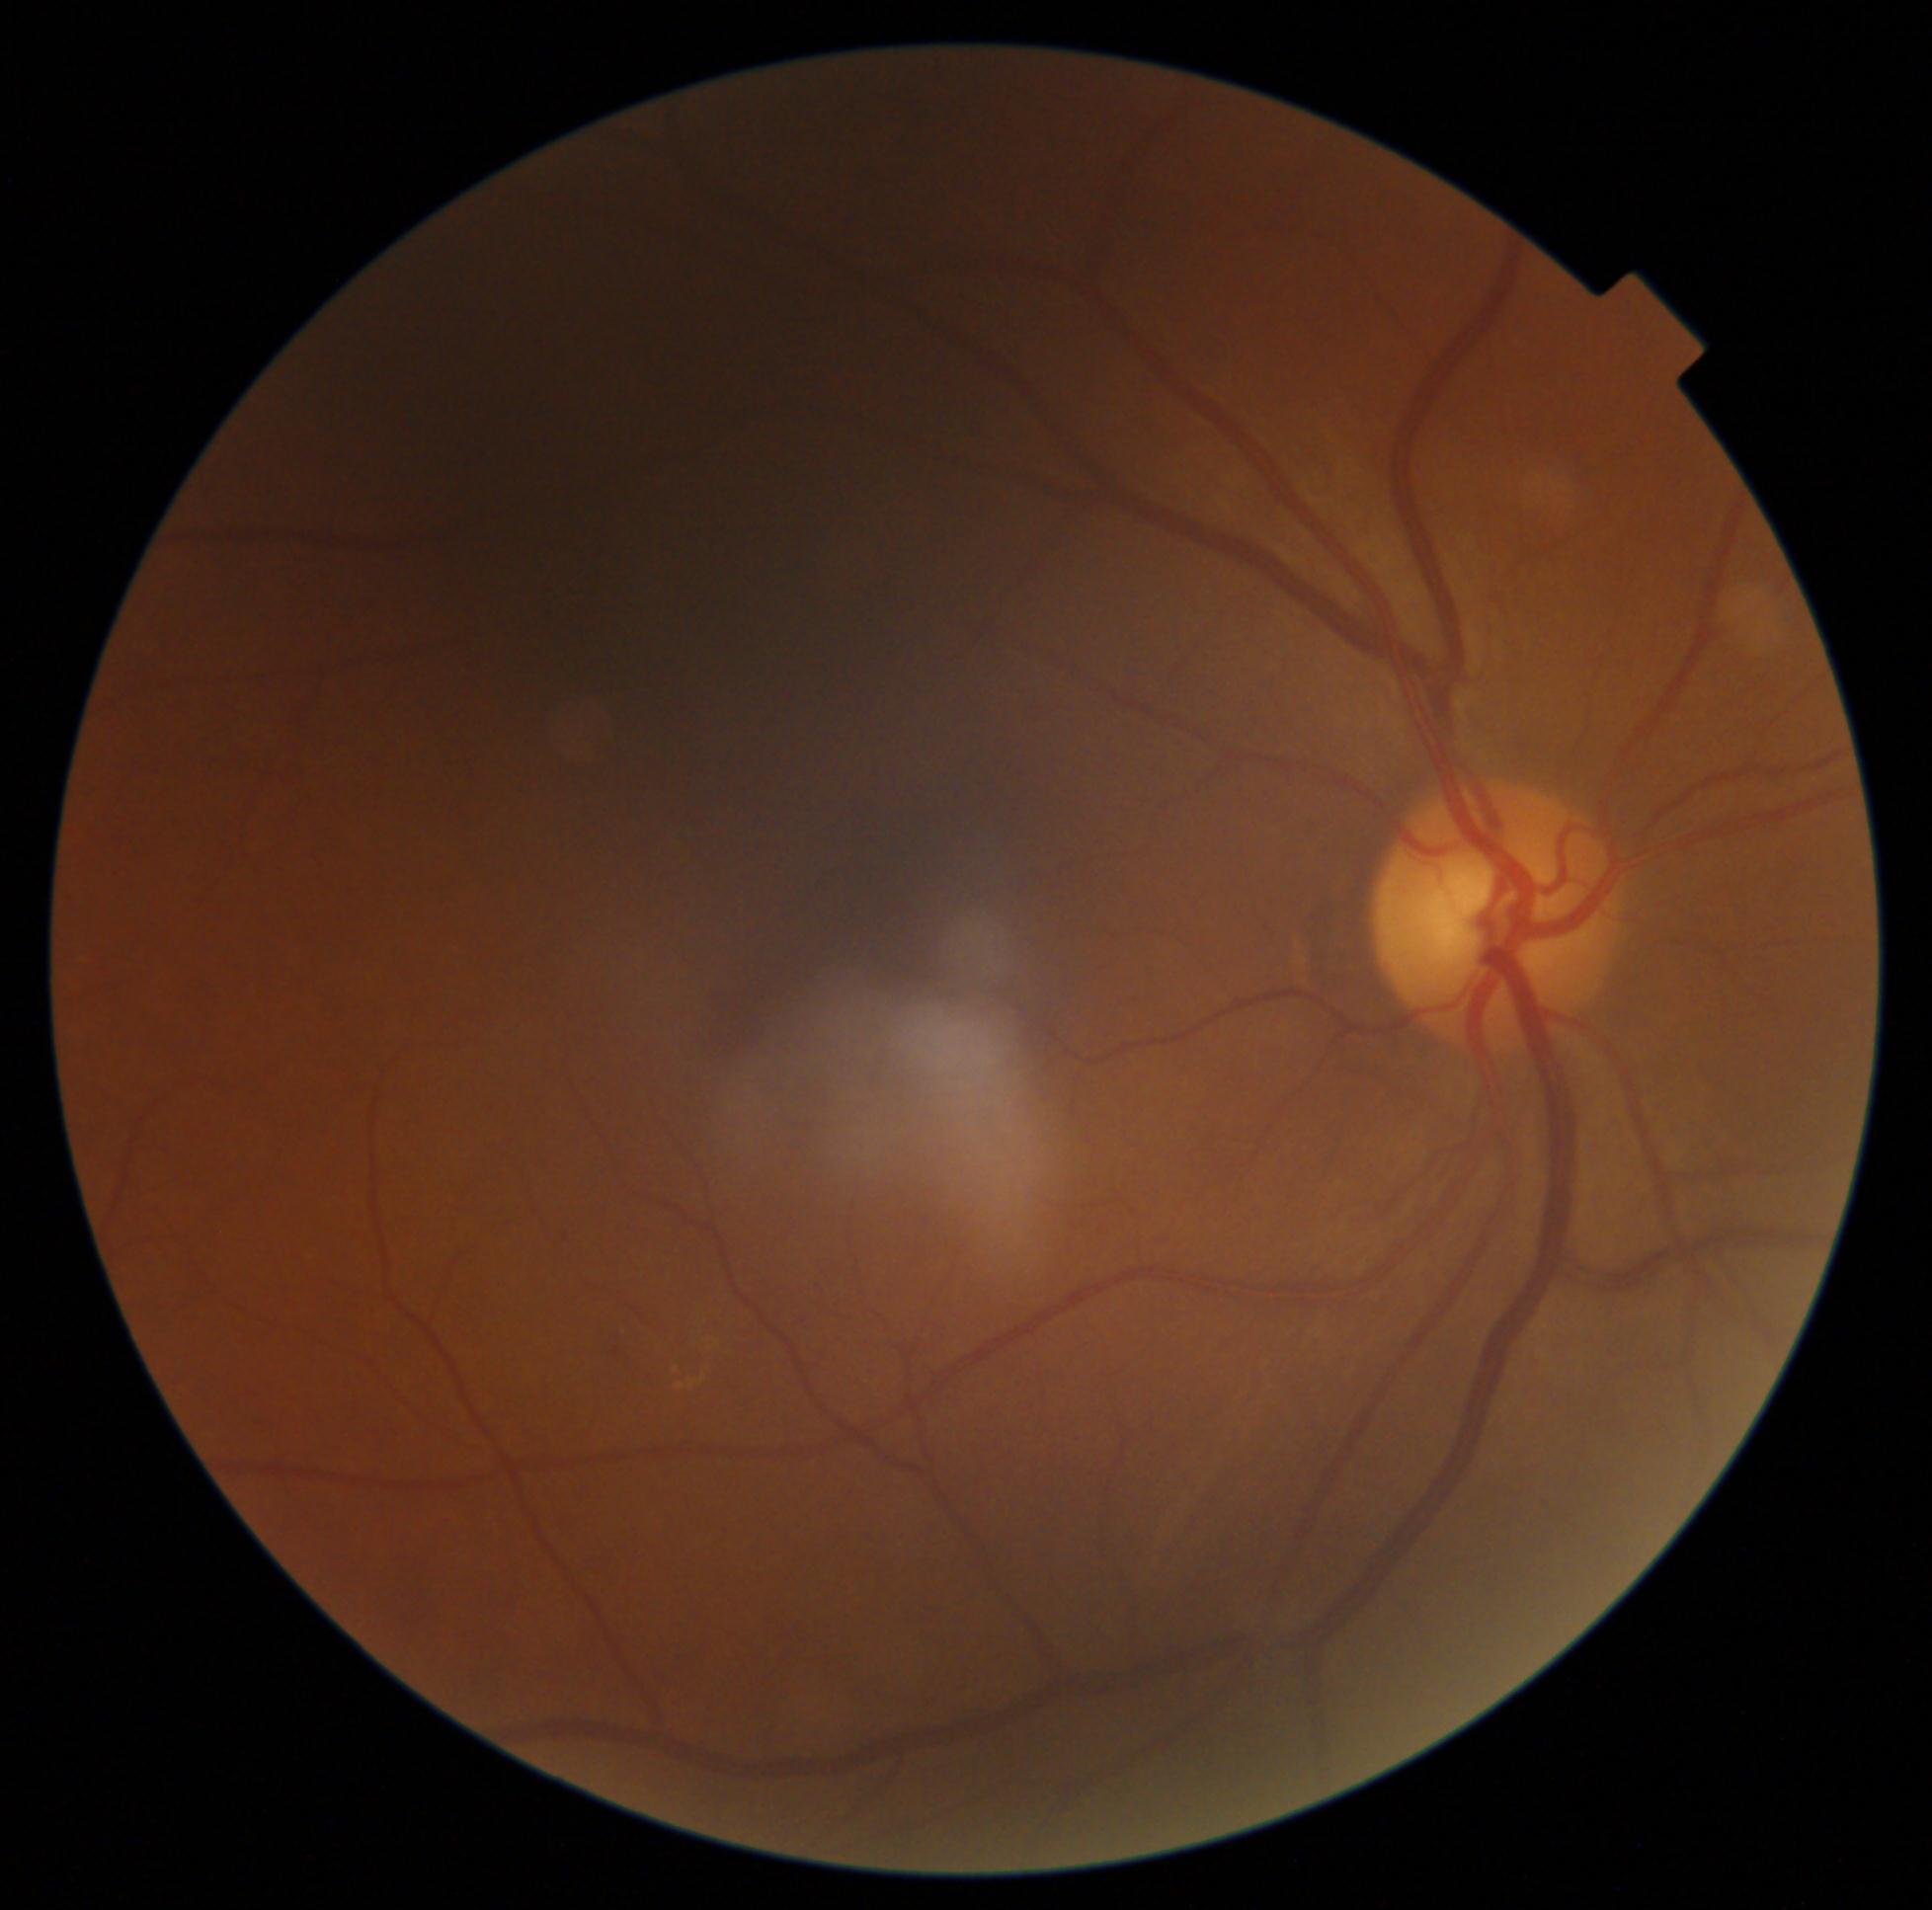
Diabetic retinopathy (DR): 2/4.
The retinopathy is classified as non-proliferative diabetic retinopathy.